Centered on the macula. Captured after pupil dilation. Camera: Kowa VX-10α. Retinal fundus photograph — 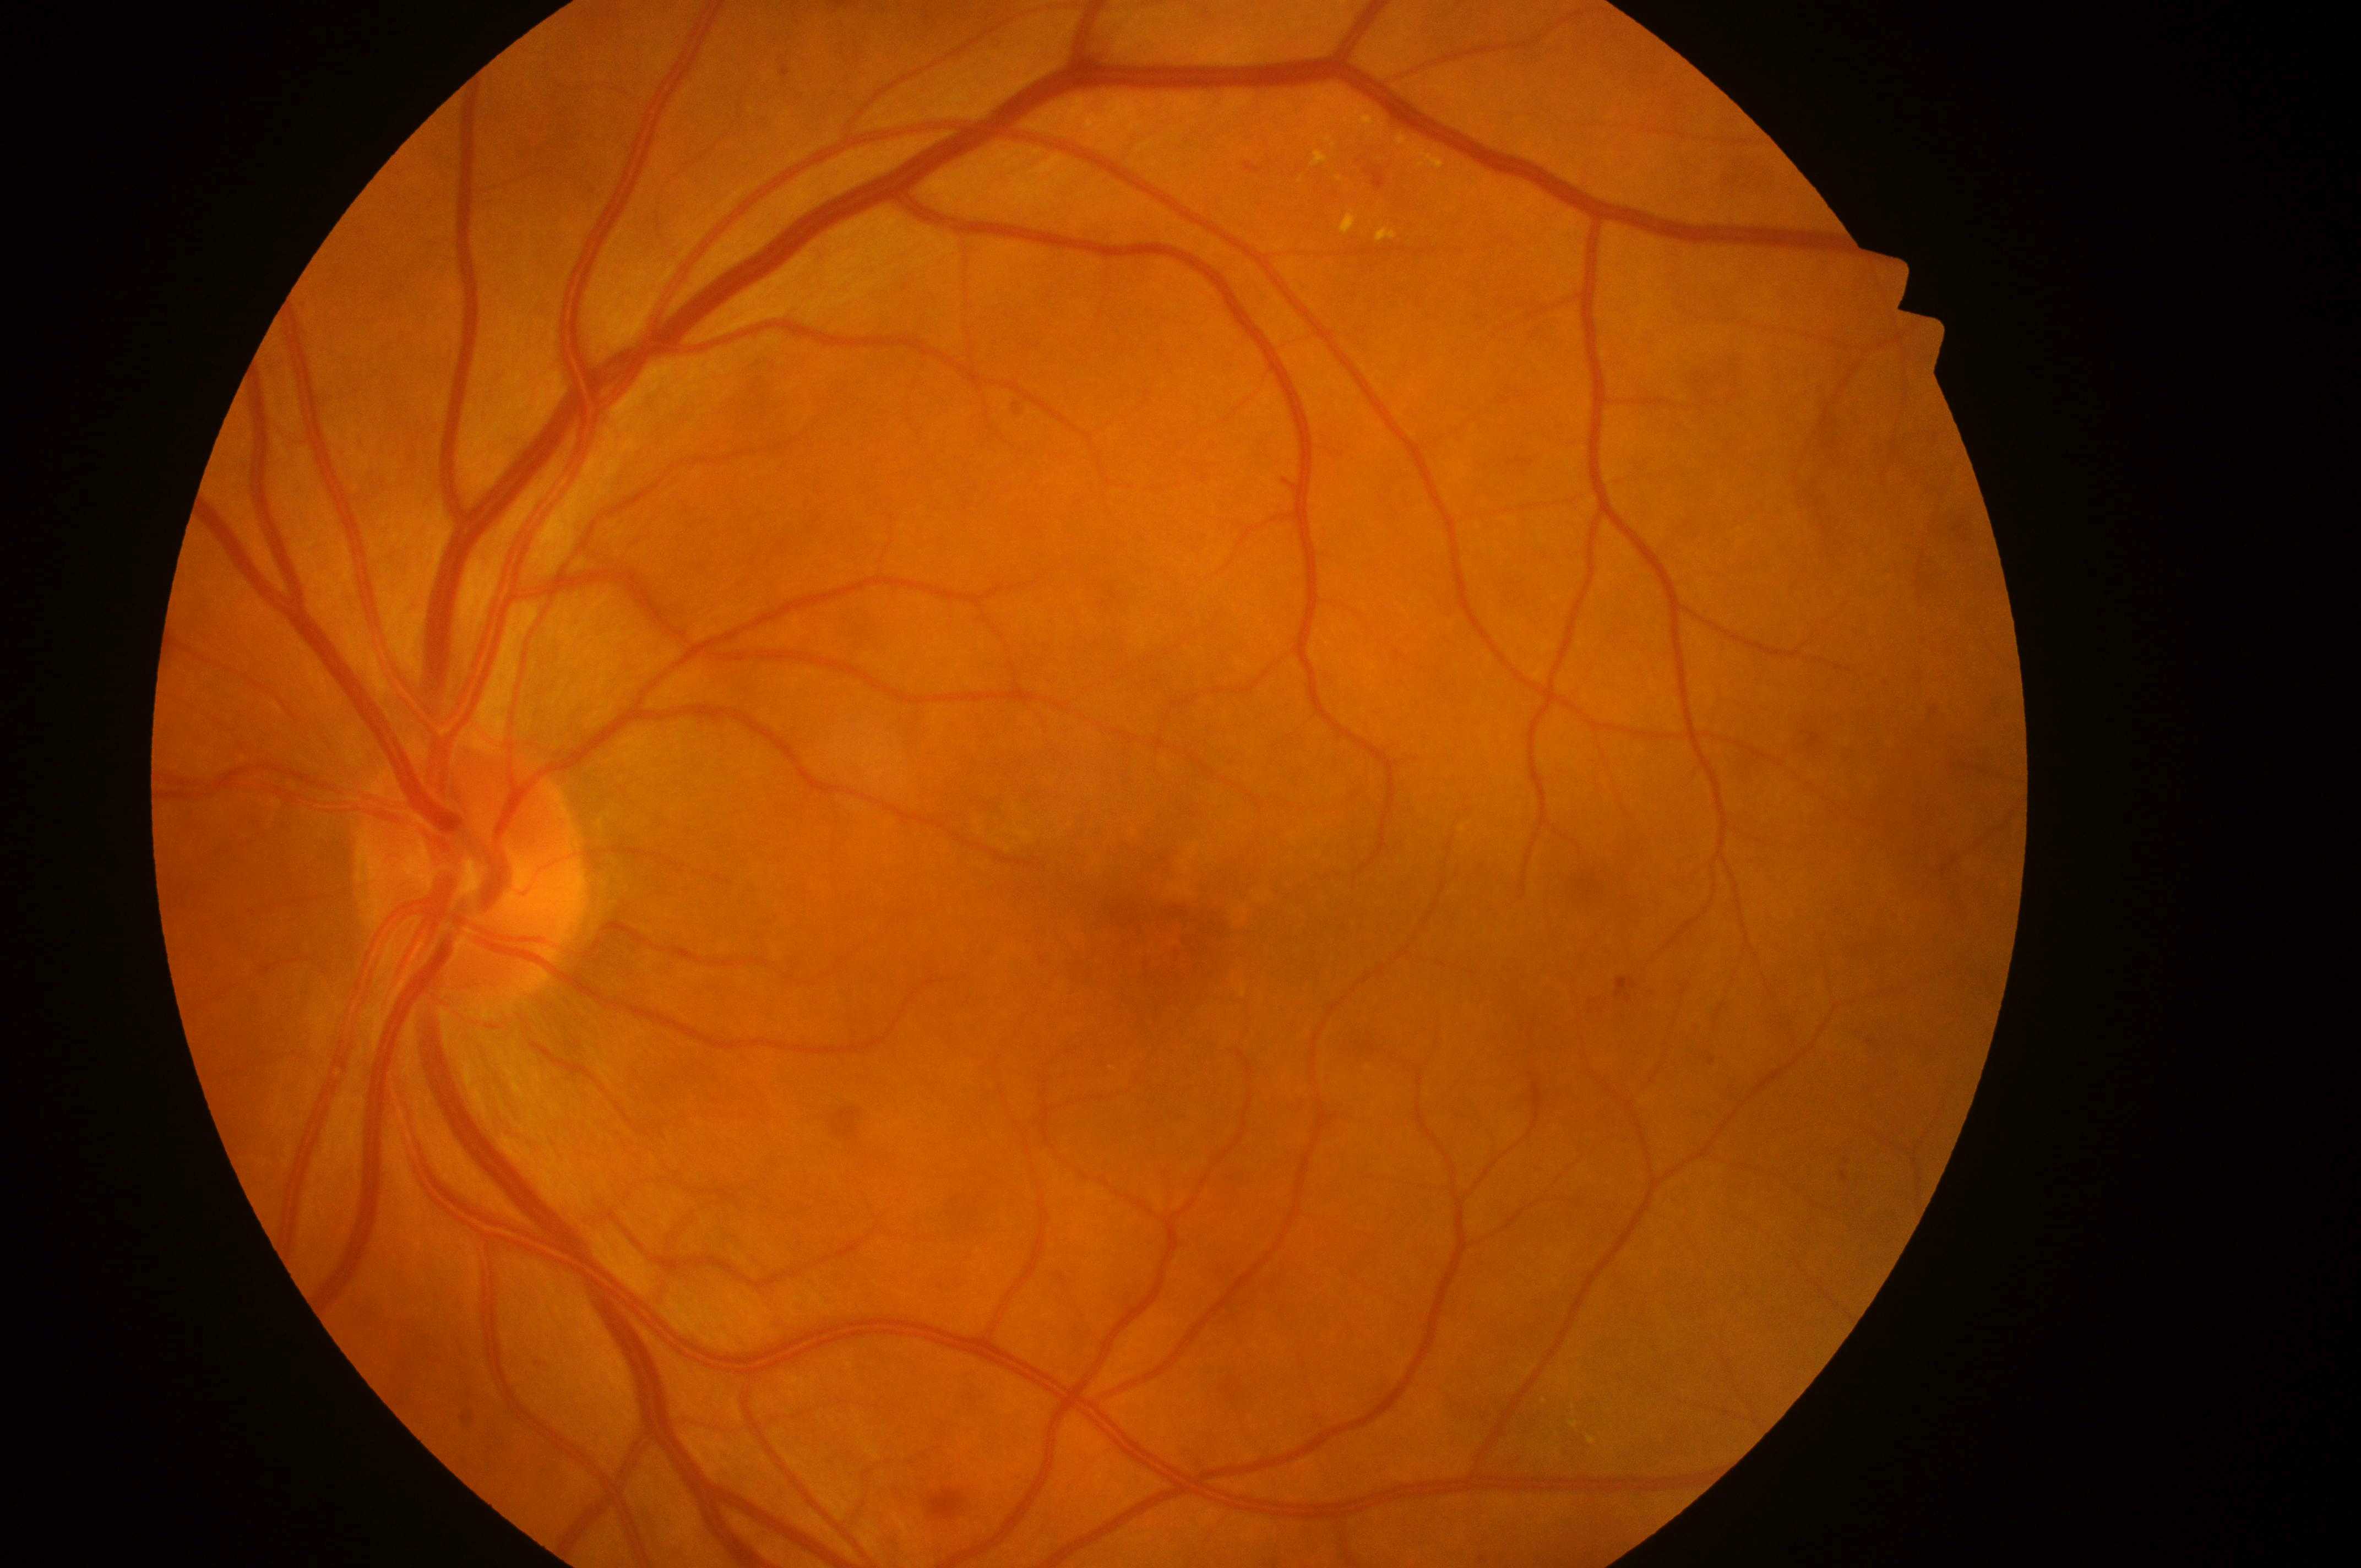 Eye: the left eye. DR stage: moderate NPDR (grade 2). DME: grade 1 (low risk). Fovea: (x: 1176, y: 946). The optic disc is at (x: 466, y: 880).